Pediatric wide-field fundus photograph; 100° field of view (Phoenix ICON) — 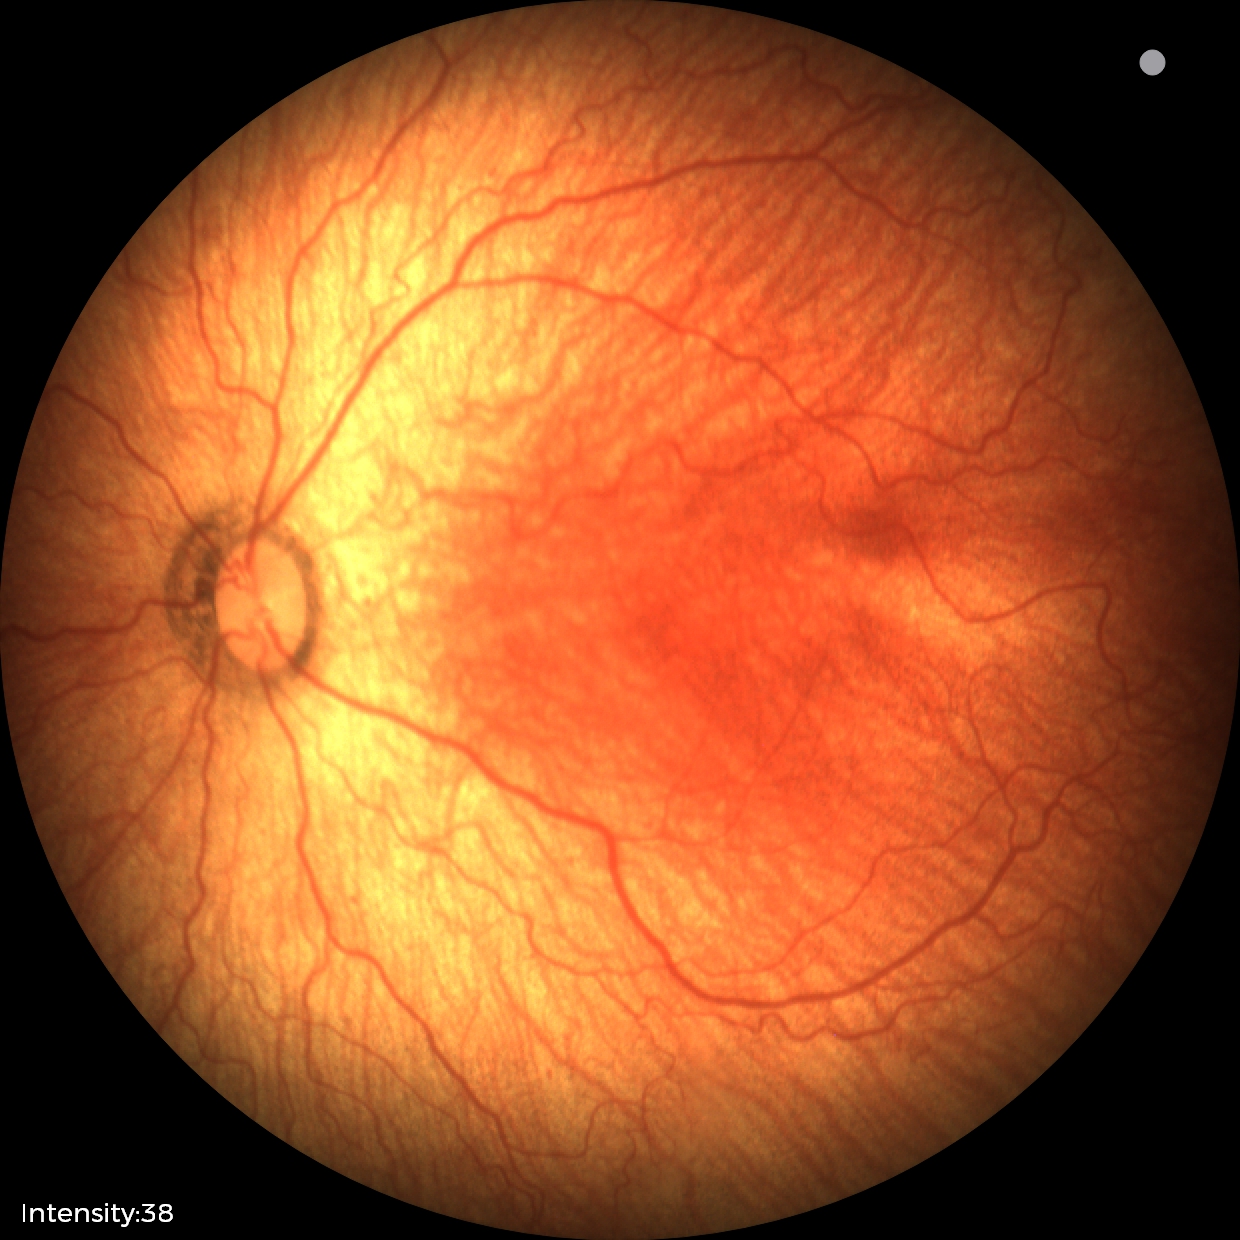
From an examination with diagnosis of retinopathy of prematurity (ROP) stage 1.